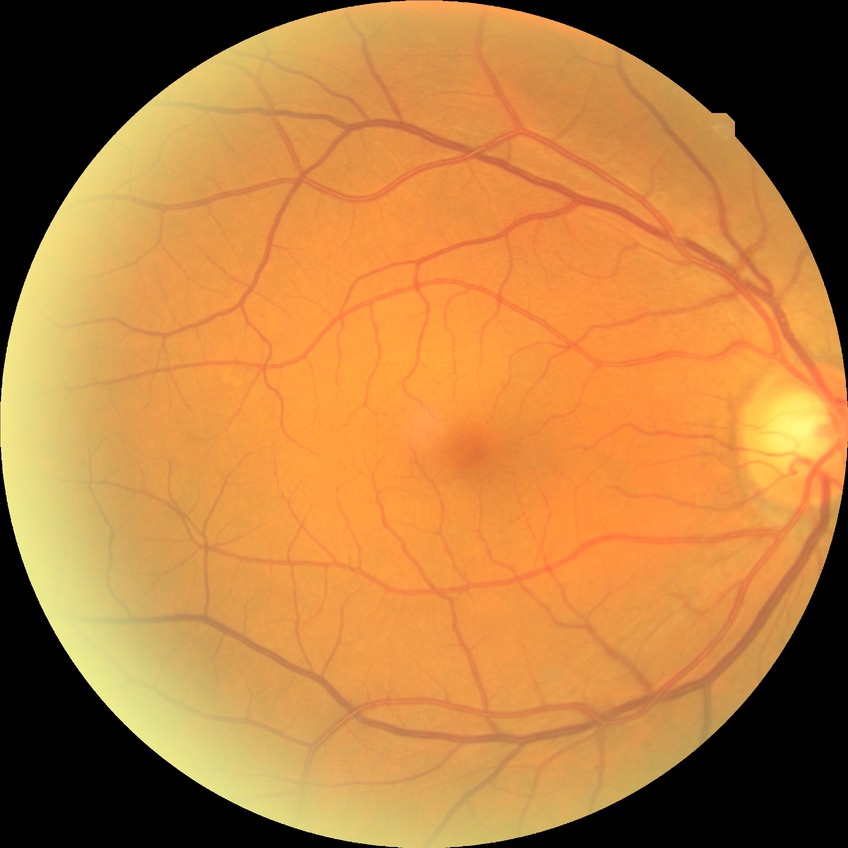
Diabetic retinopathy (DR) is NDR (no diabetic retinopathy).